Captured with pupil dilation. FOV 35° before cropping. Optic disc region of a color fundus photo.
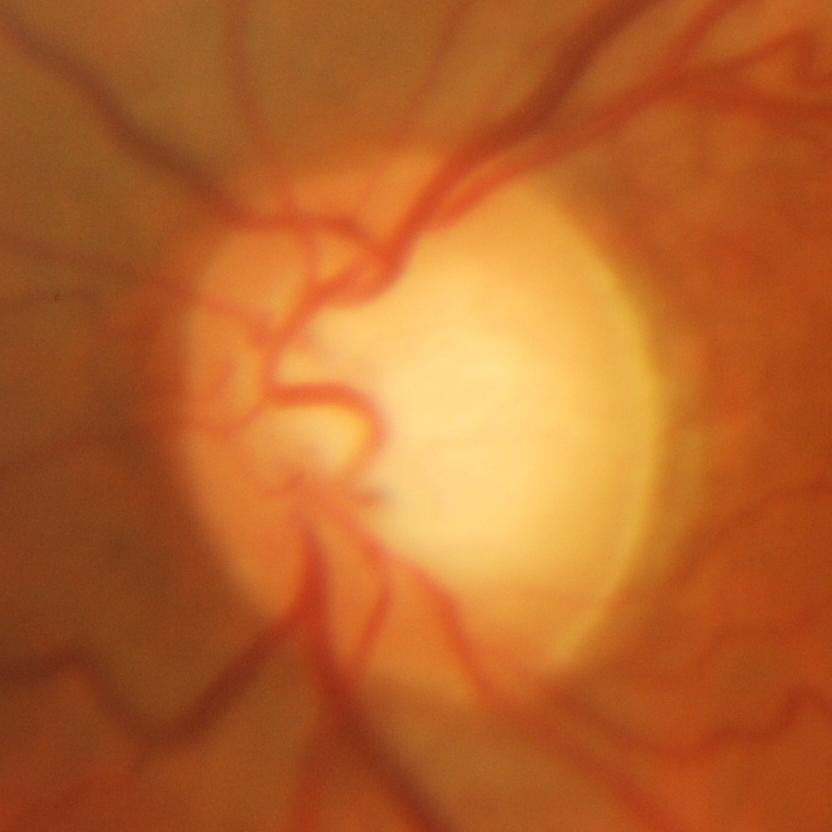
Glaucomatous optic neuropathy is present.
Glaucomatous damage to the optic nerve.